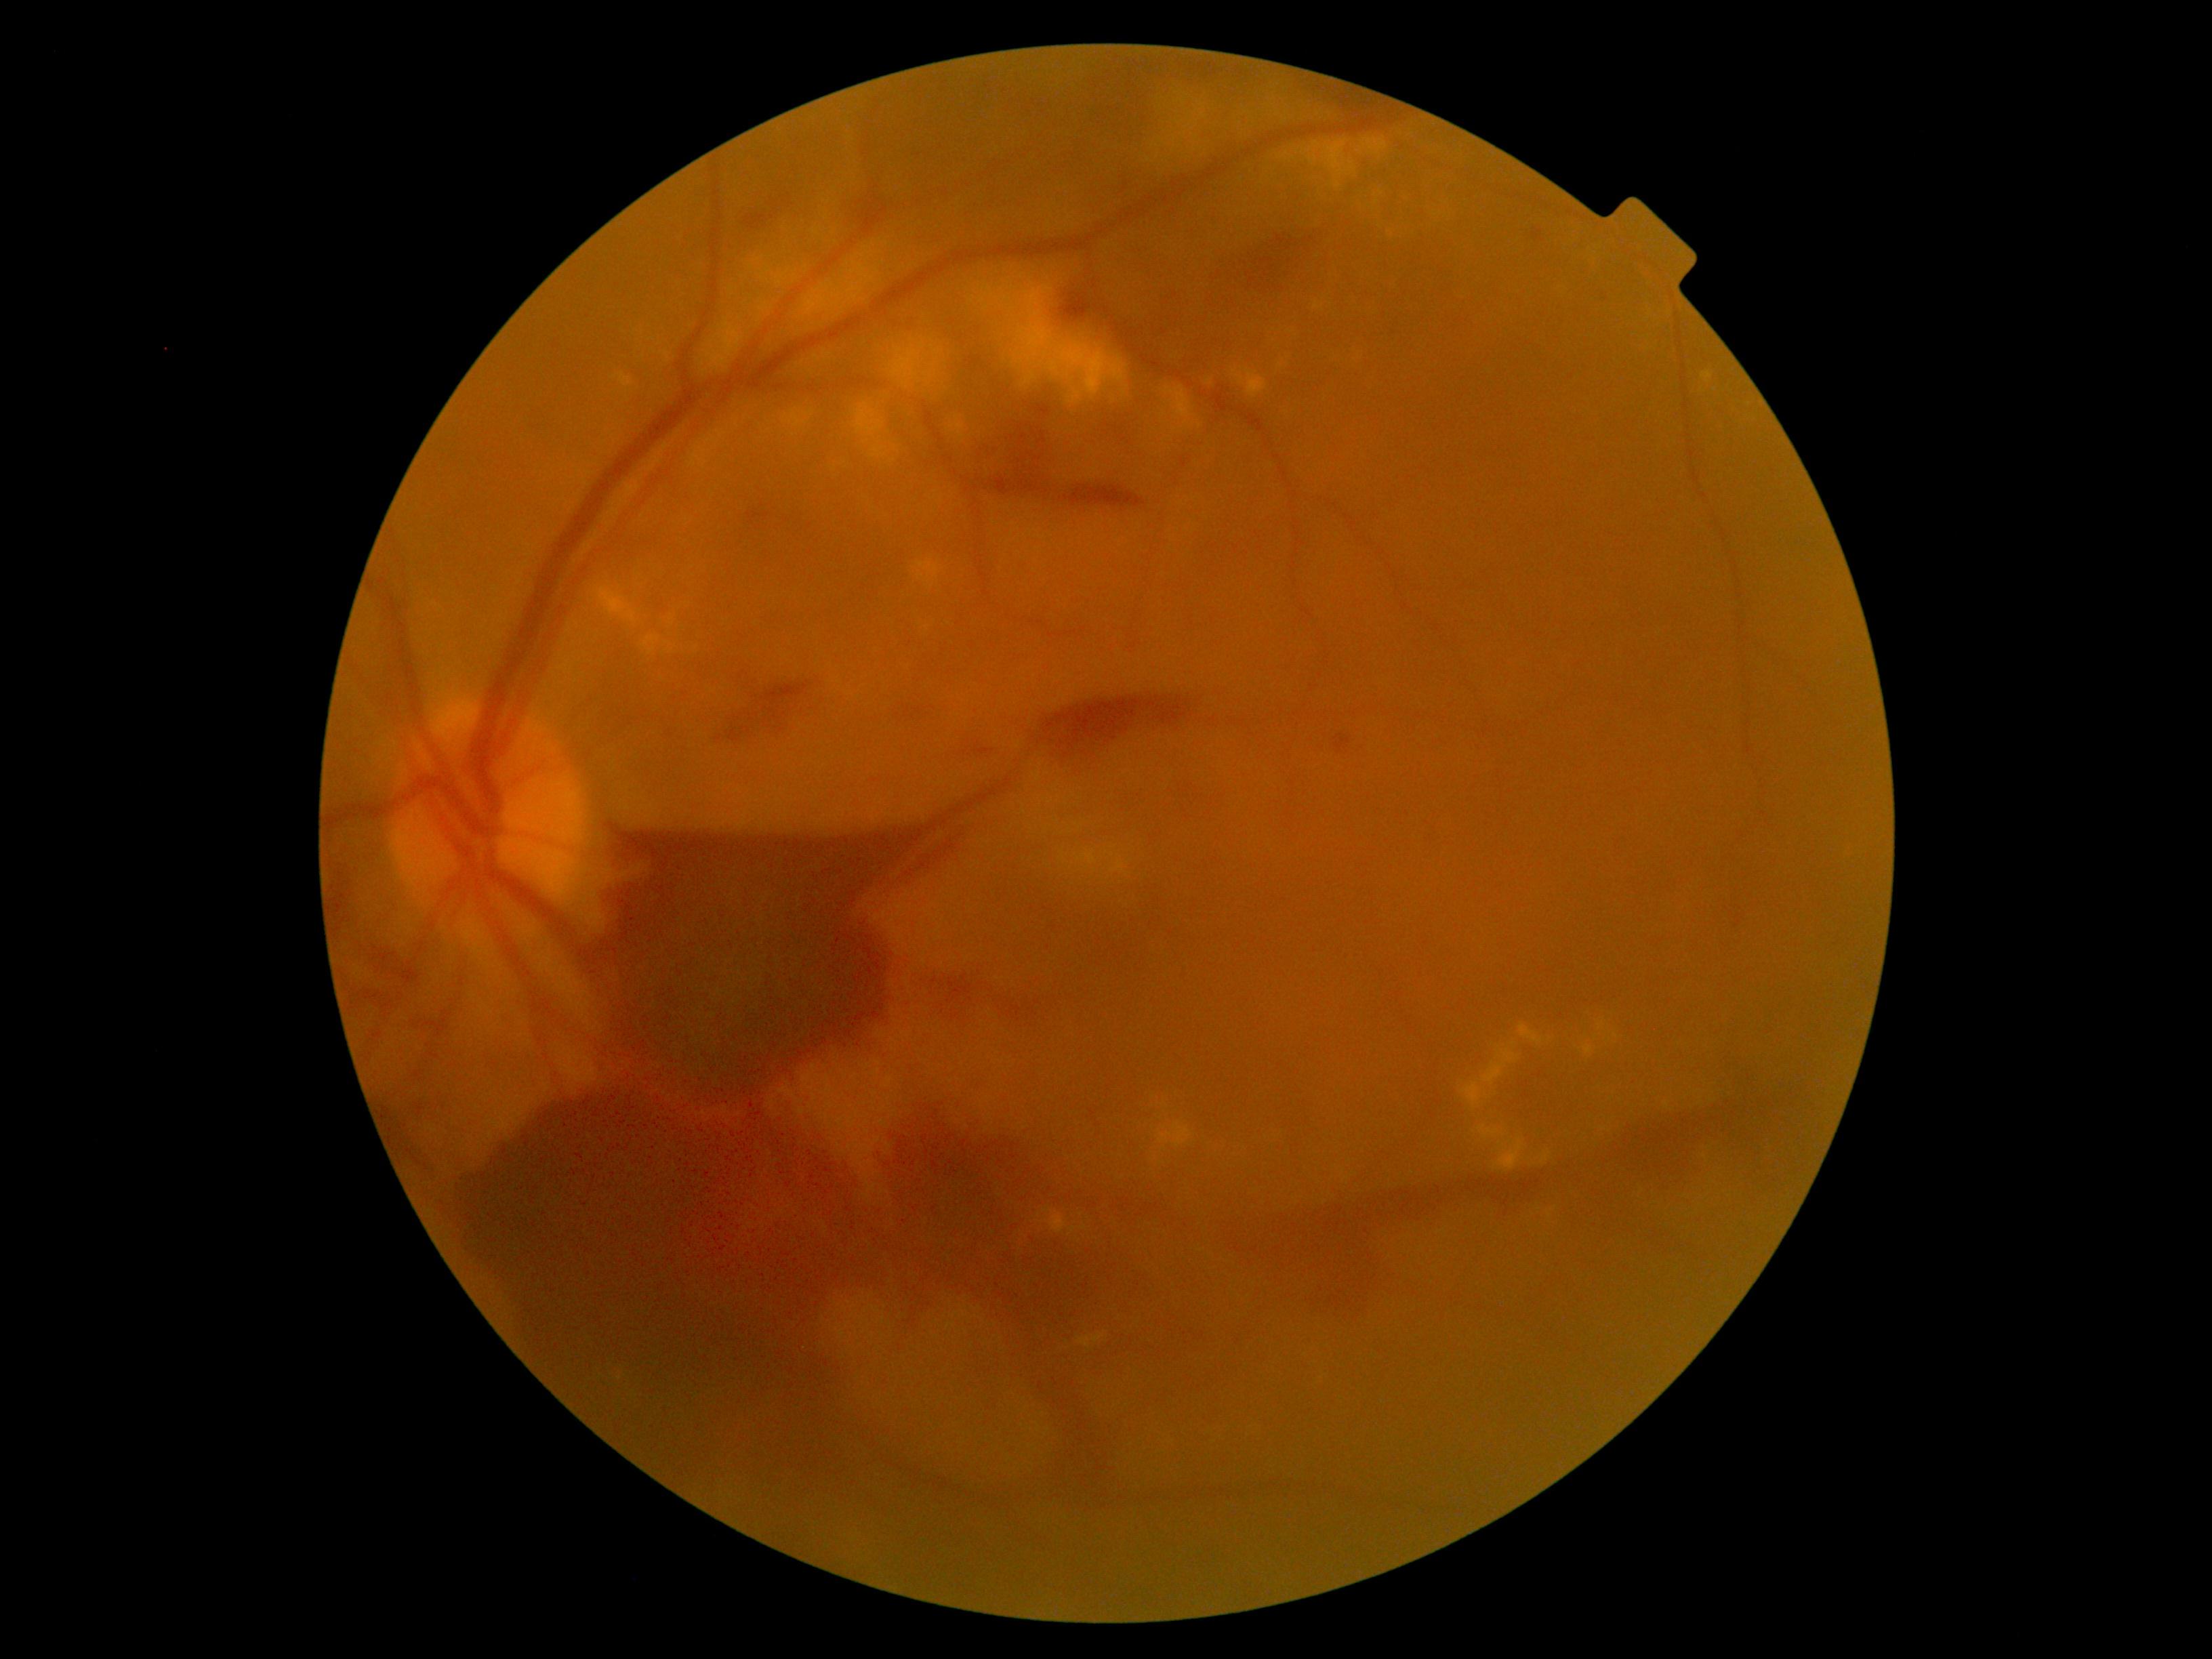

partial: true
dr_grade: 4
dr_grade_name: PDR
lesions:
  ex:
    - left=777, top=270, right=791, bottom=285
    - left=758, top=303, right=771, bottom=312
    - left=1357, top=138, right=1389, bottom=157
    - left=803, top=410, right=814, bottom=417
    - left=612, top=372, right=634, bottom=387
    - left=1165, top=387, right=1193, bottom=428
    - left=890, top=341, right=955, bottom=392
    - left=1248, top=89, right=1314, bottom=127
    - left=1436, top=201, right=1450, bottom=213
    - left=1462, top=1082, right=1482, bottom=1108
    - left=1393, top=220, right=1412, bottom=234
    - left=1352, top=350, right=1360, bottom=361
  ex_small_approx:
    - <point>816, 359</point>
    - <point>740, 318</point>
    - <point>1128, 388</point>
    - <point>1514, 1045</point>
    - <point>1200, 426</point>
    - <point>1287, 156</point>